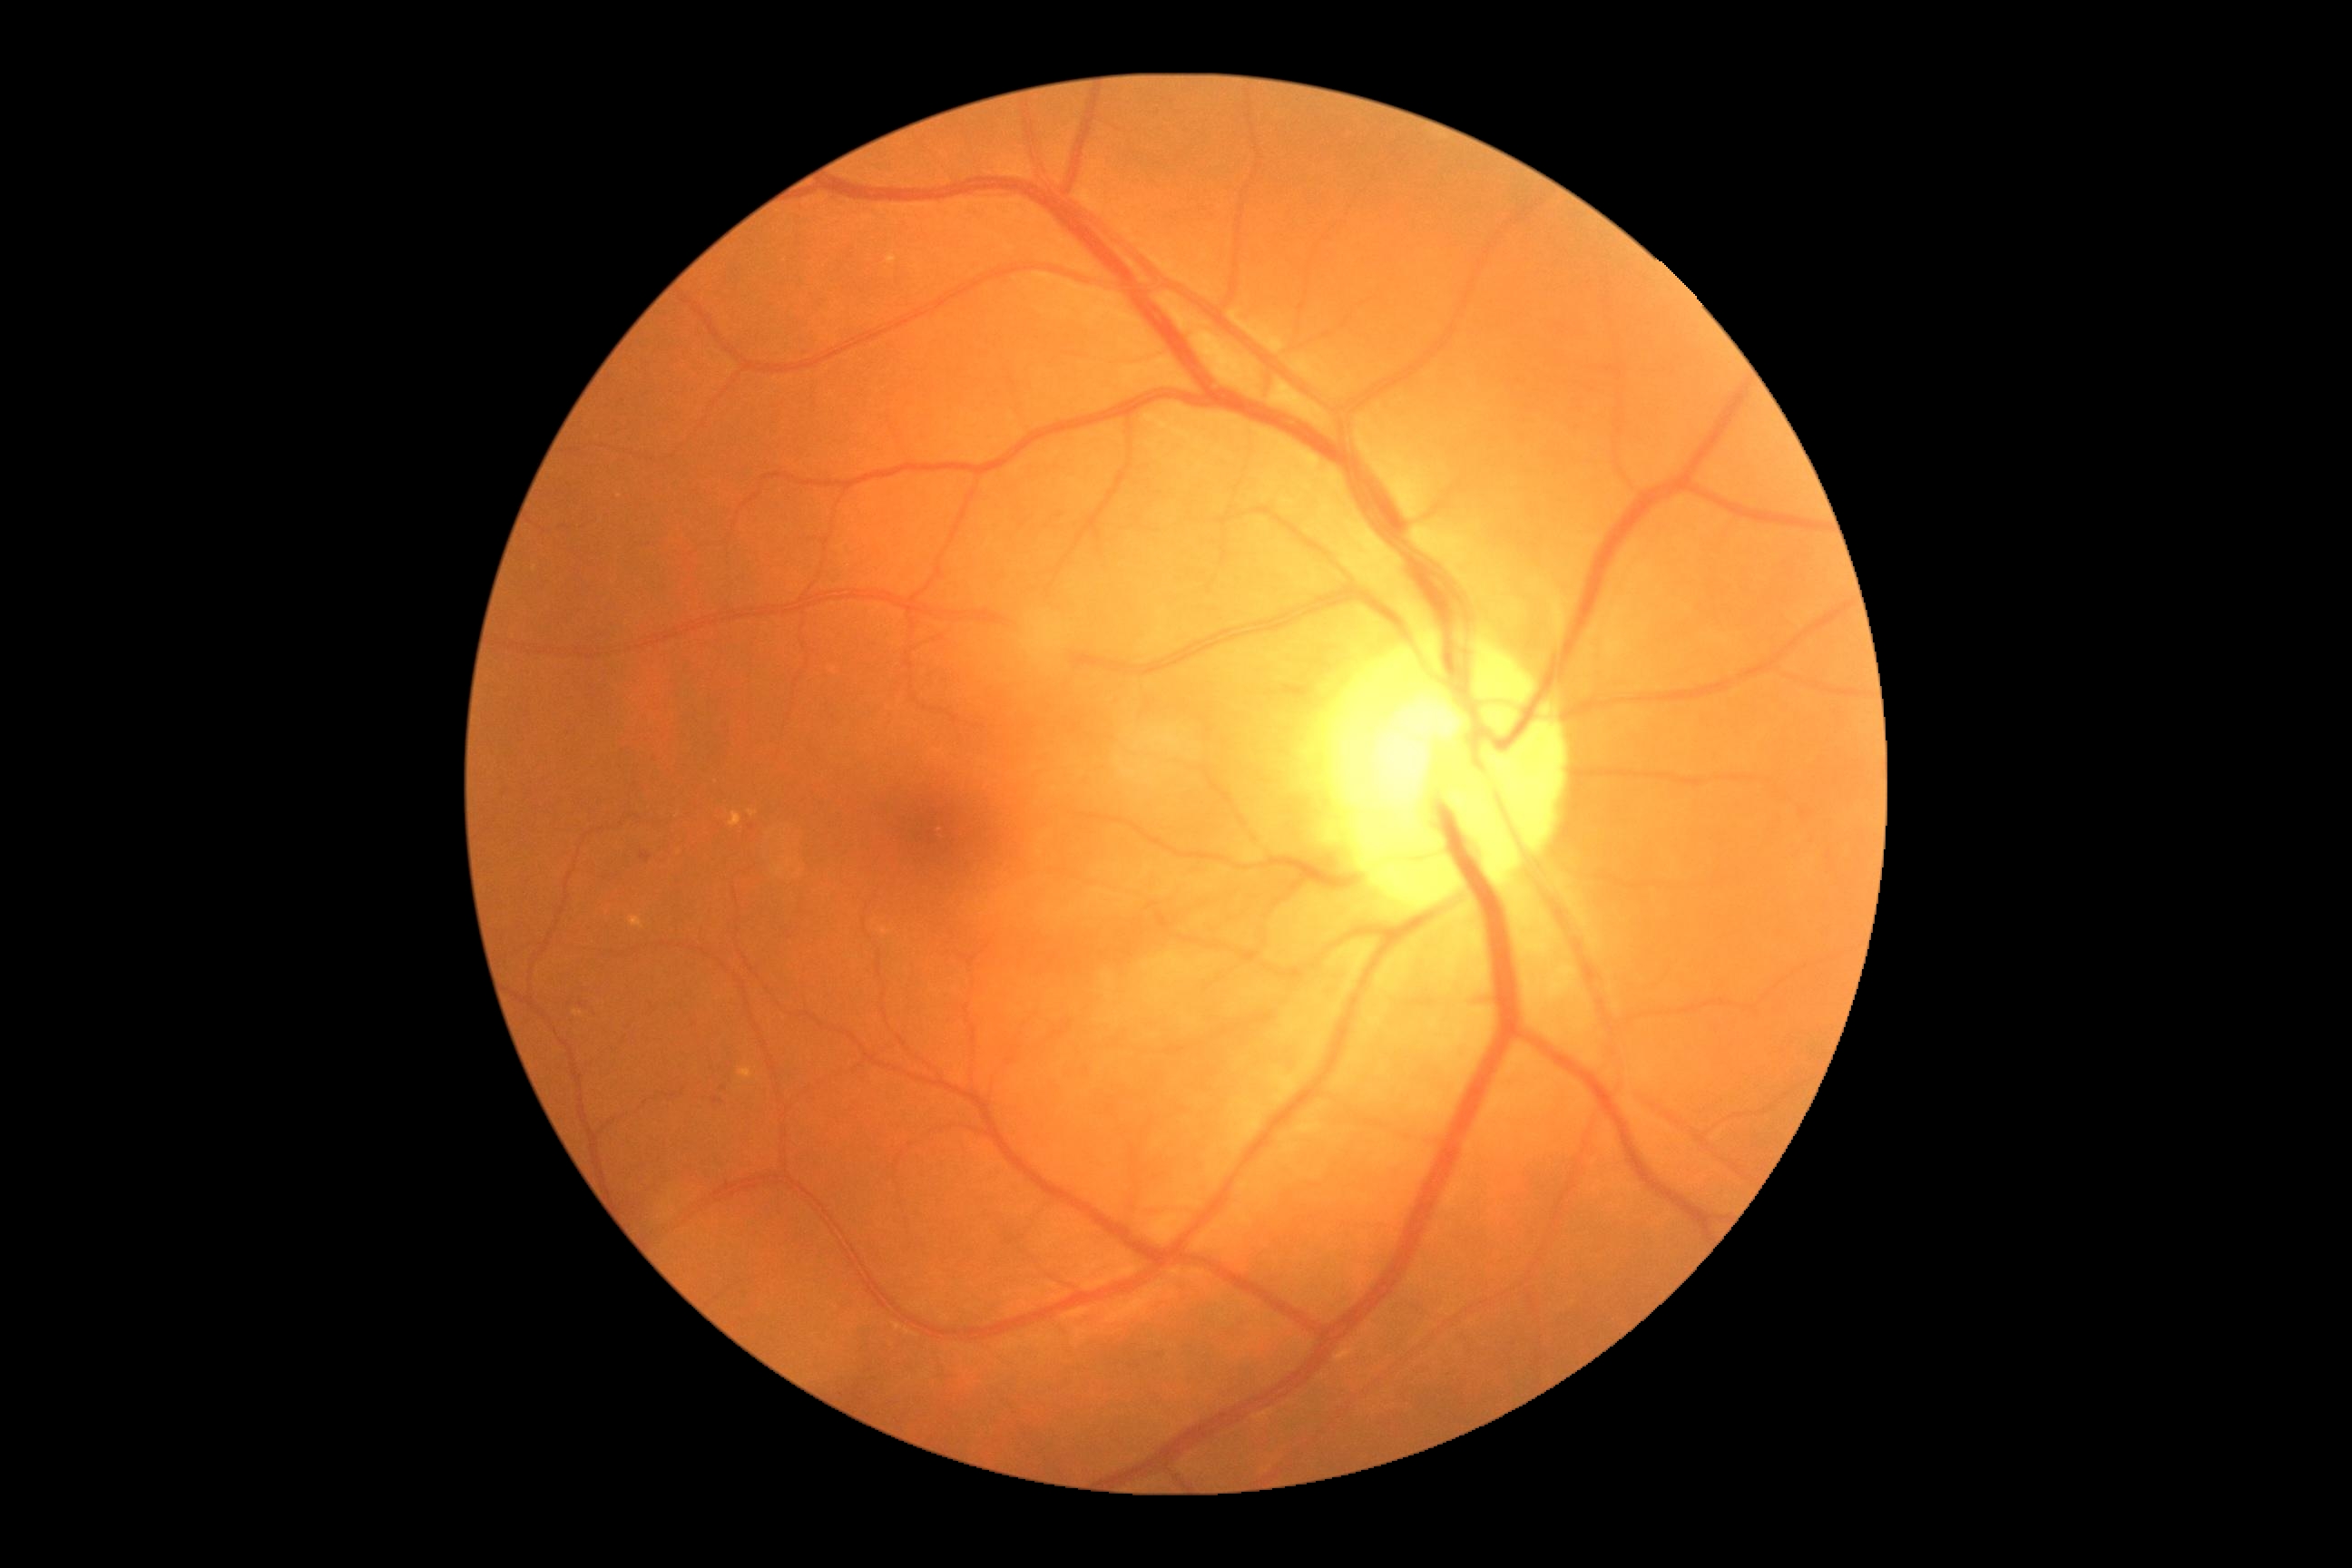

DR stage: grade 2
Representative lesions:
MAs: not present
HEs: <box>569,997,596,1015</box>; <box>1275,683,1309,698</box>; <box>712,1097,725,1104</box>; <box>651,756,660,763</box>; <box>642,854,652,863</box>; <box>796,344,814,358</box>
Small HEs near (723,1088); (752,828)
SEs: not present
EXs (subset): <box>574,1012,583,1017</box>; <box>887,255,897,264</box>; <box>881,928,890,936</box>; <box>738,1068,754,1081</box>; <box>629,917,645,928</box>; <box>730,812,743,828</box>
Small EXs near (534,569); (752,813); (620,496)